2352 x 1568 pixels · CFP: 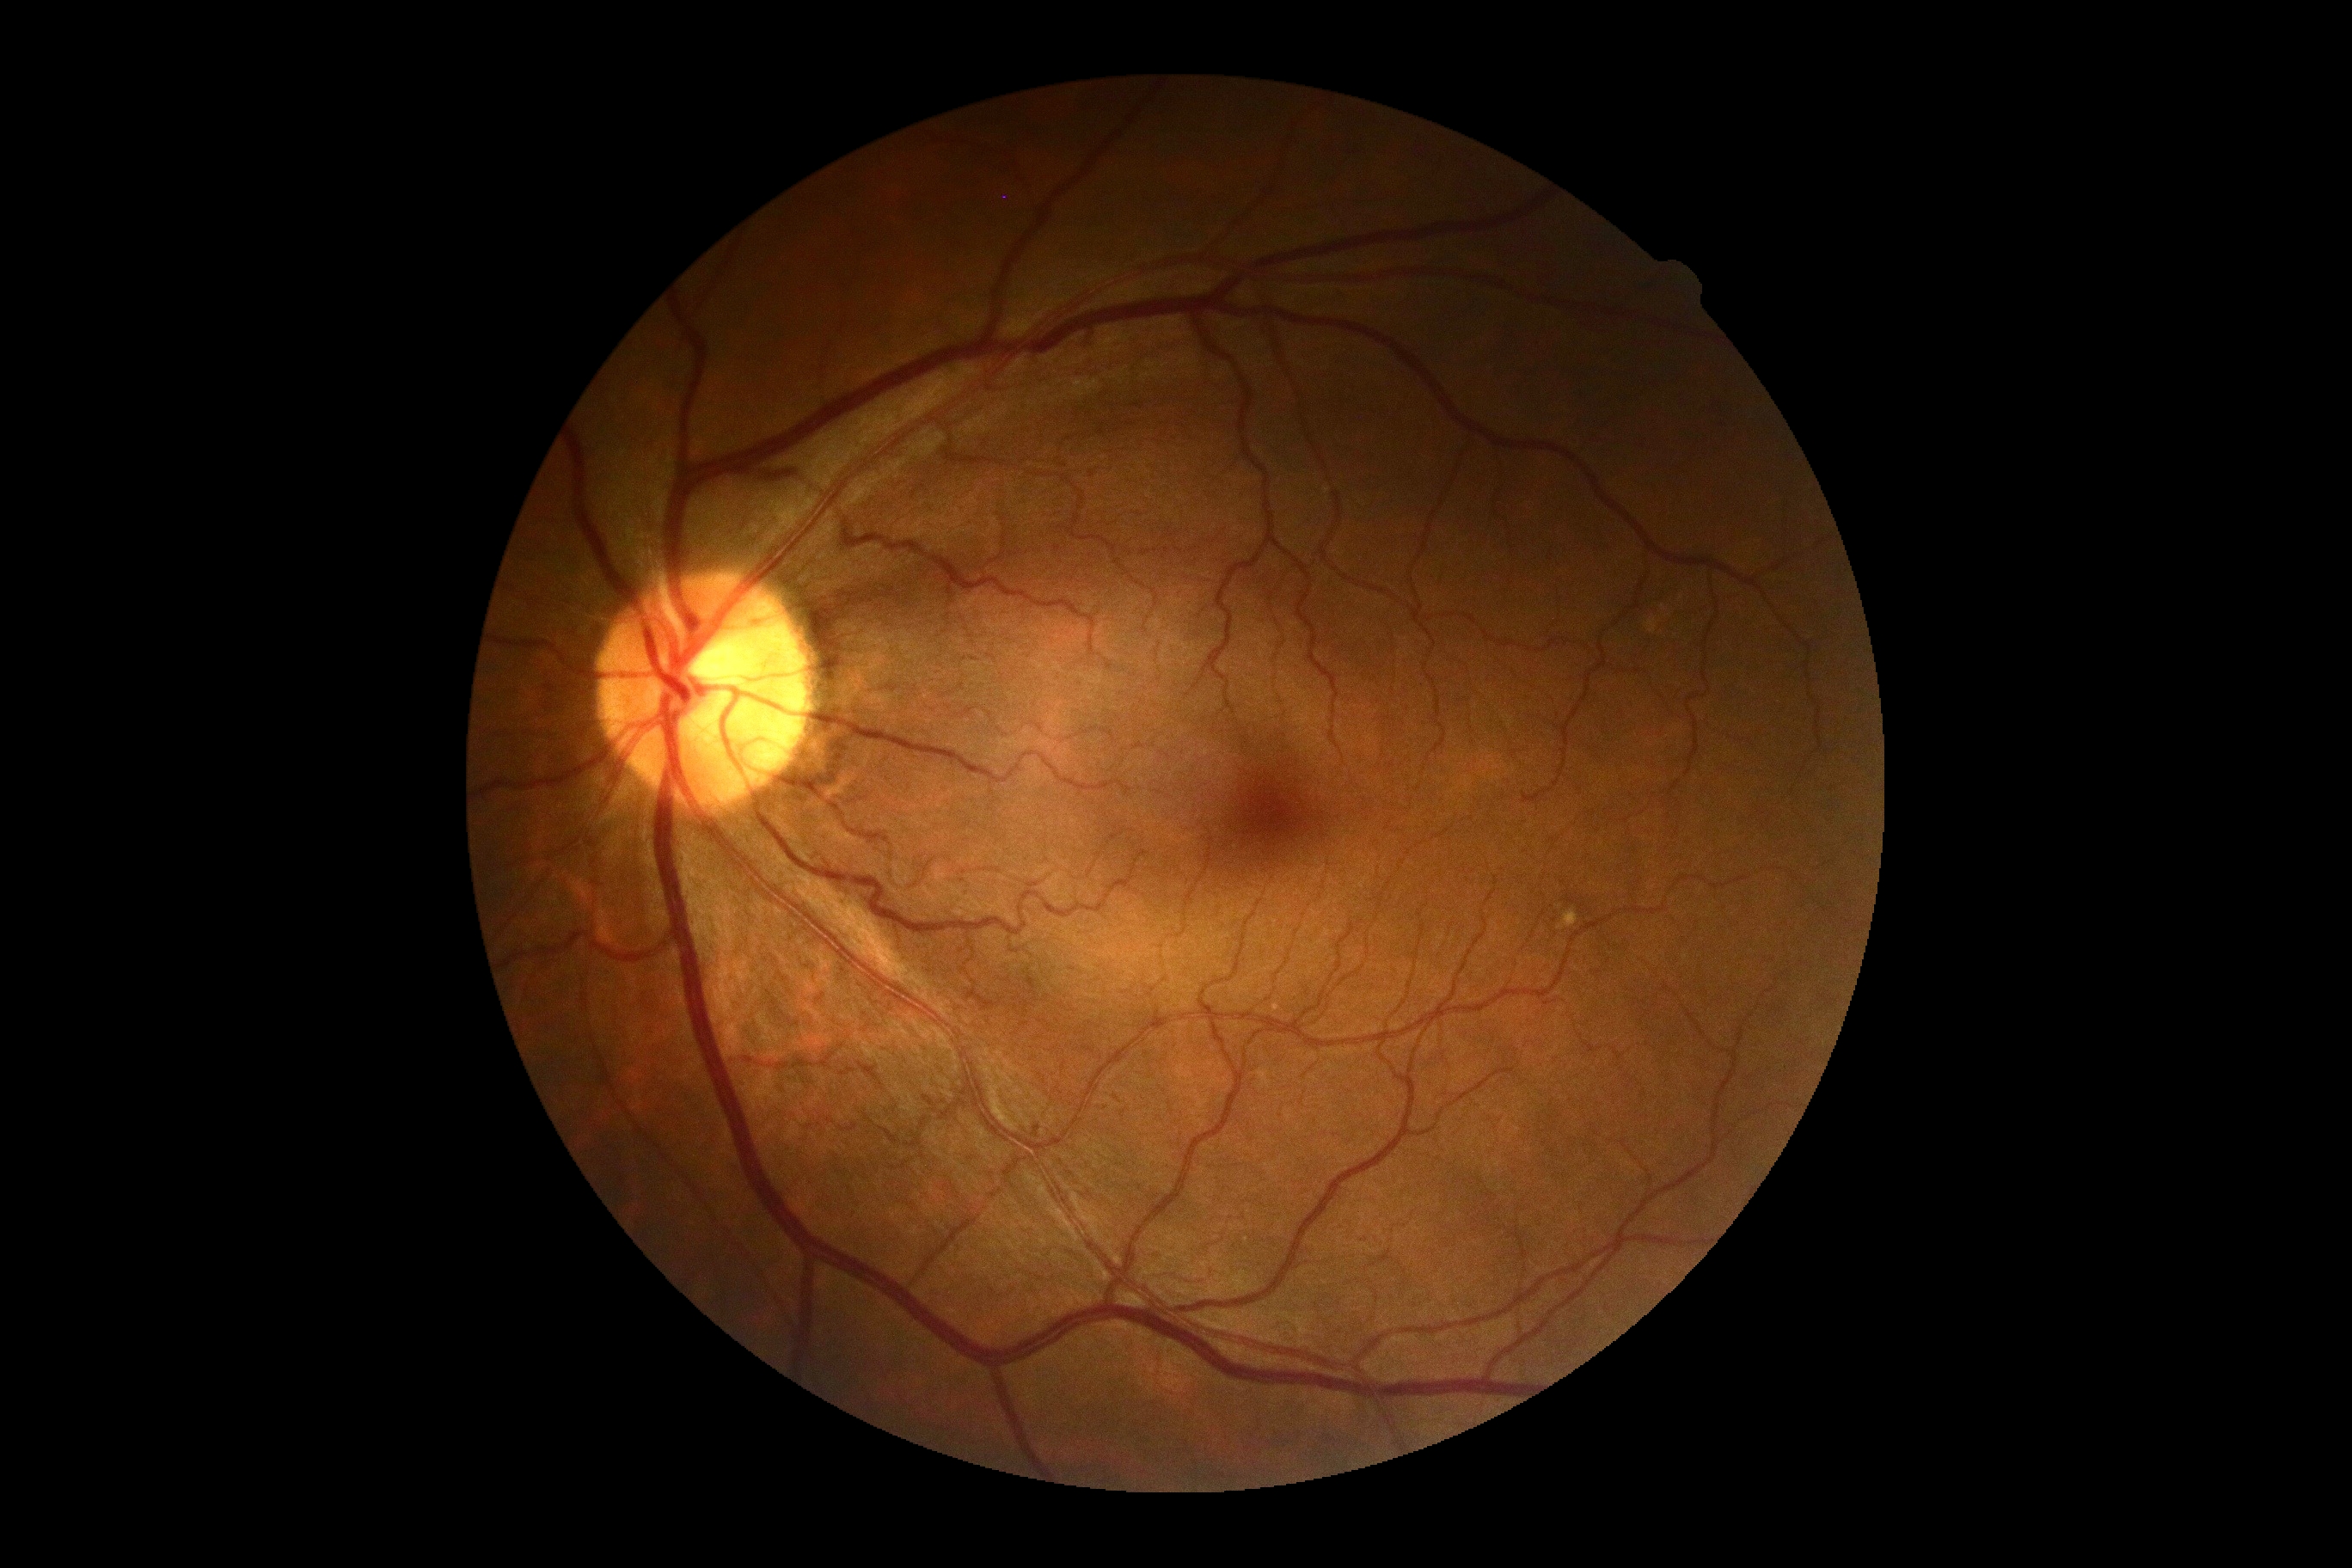

Diabetic retinopathy is grade 0 (no apparent retinopathy).